2142 by 1609 pixels. CFP — 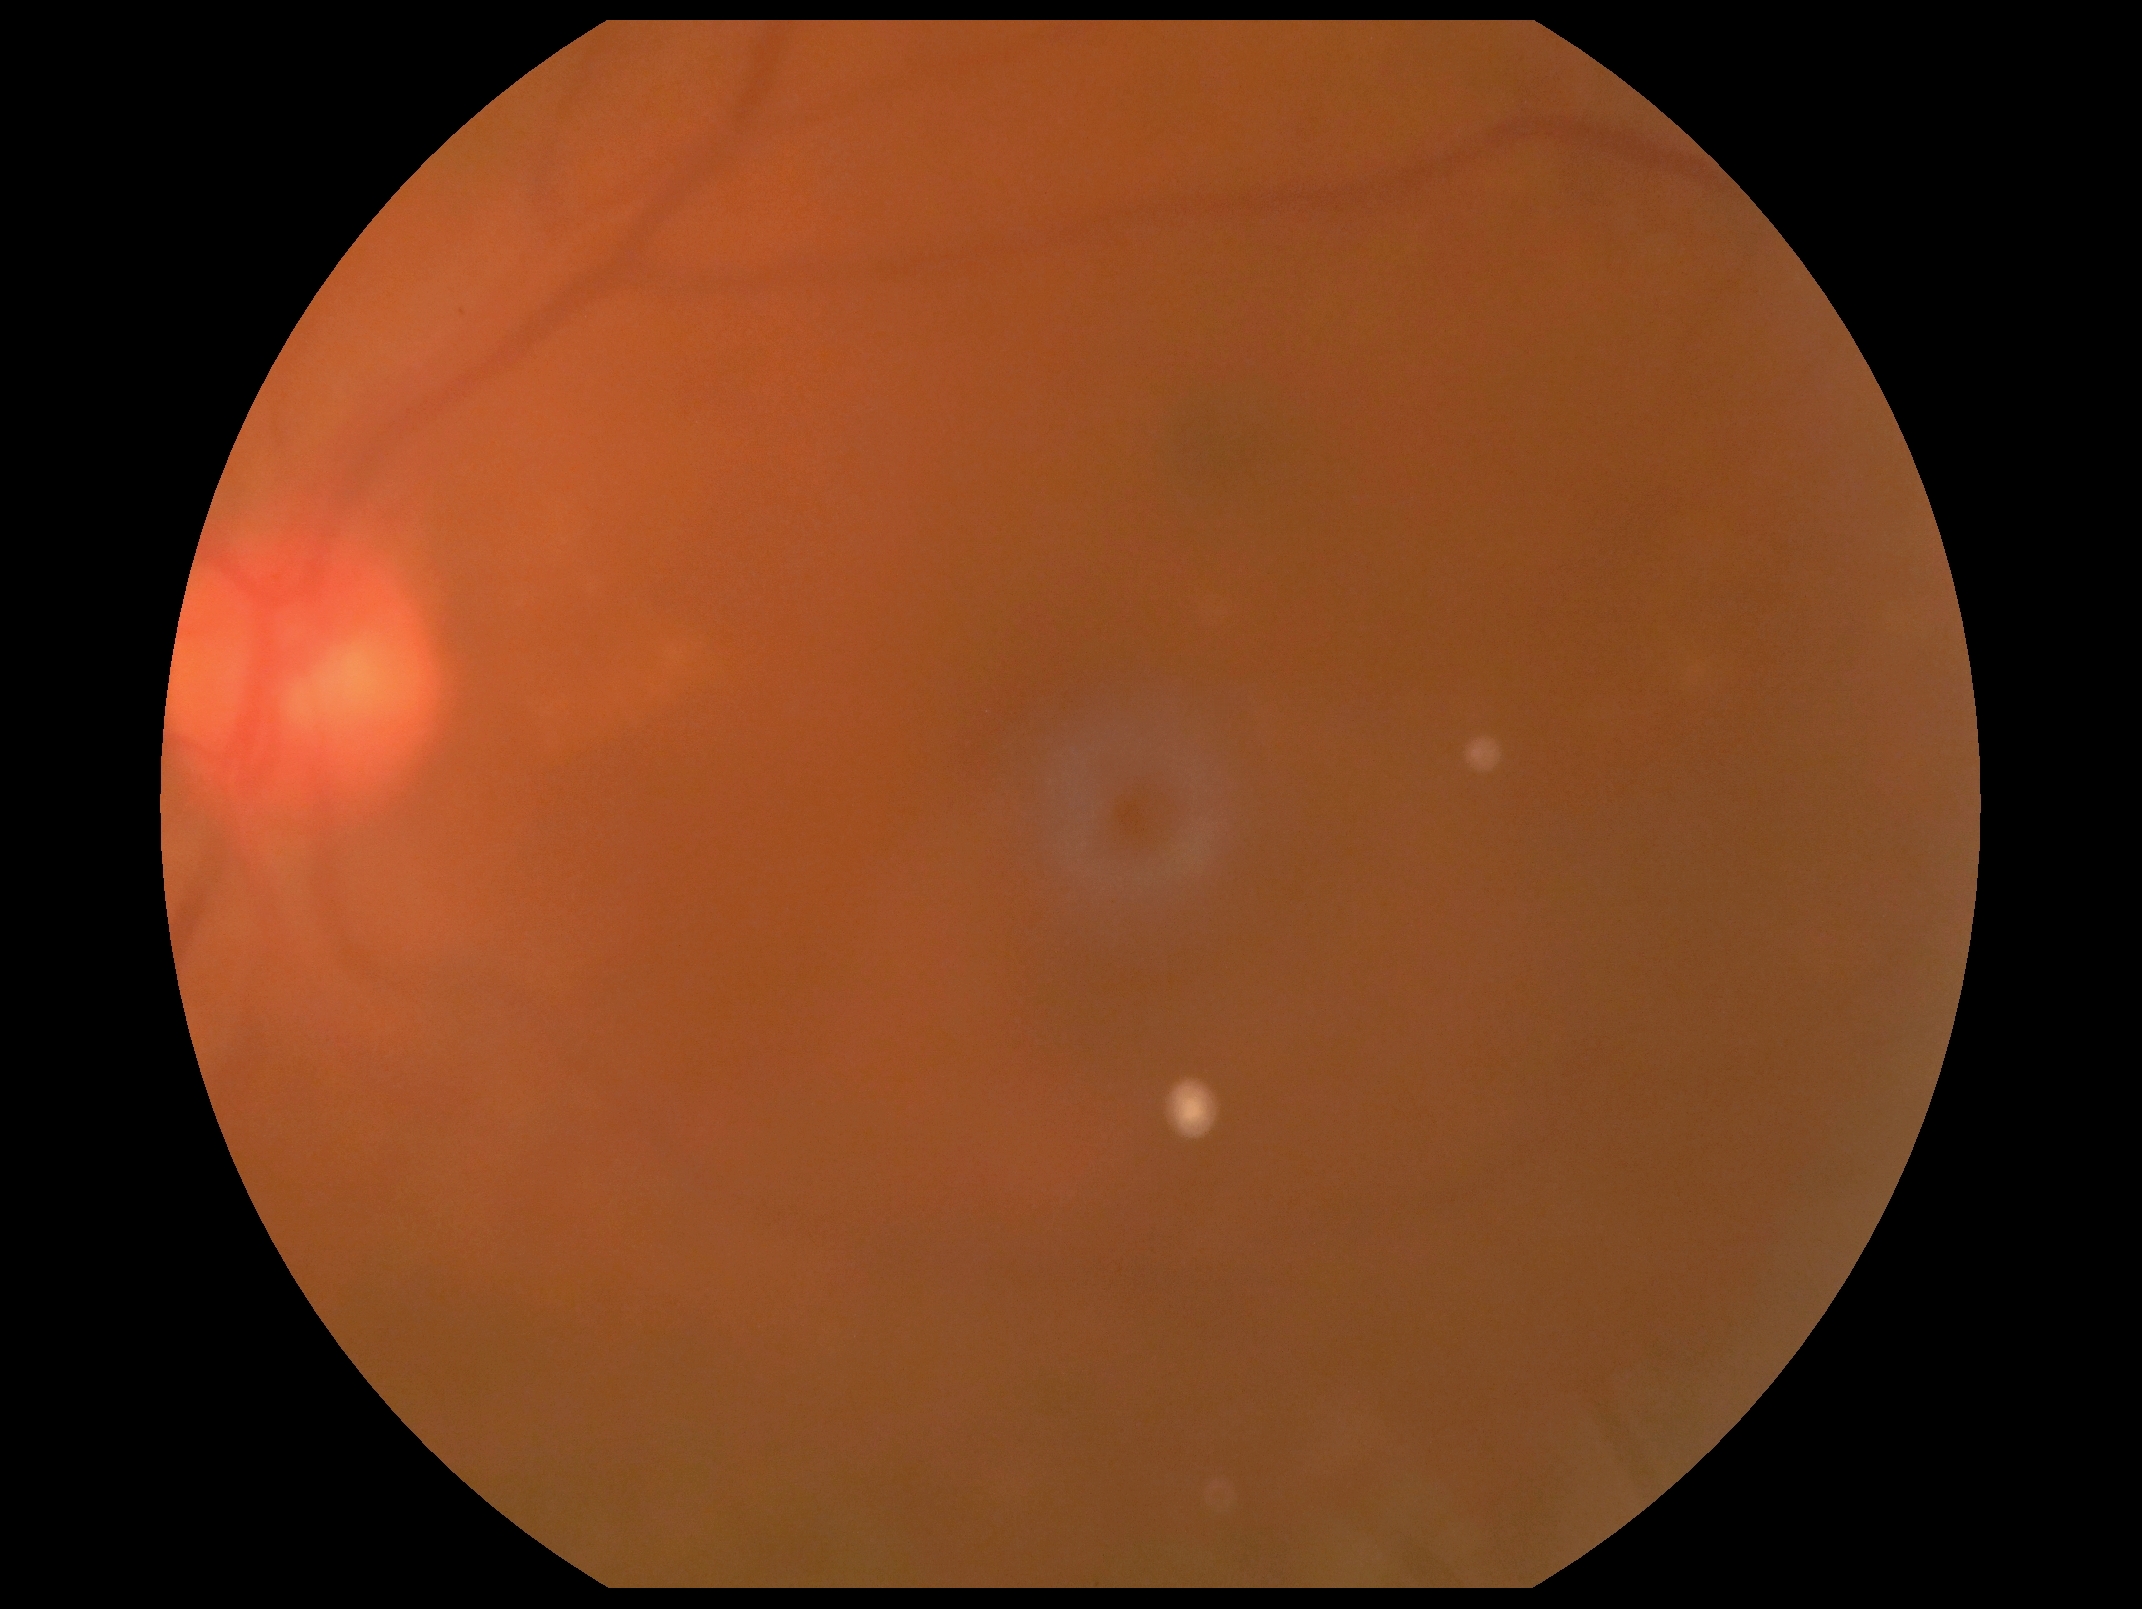

diabetic retinopathy grade: ungradable.